848x848px. Graded on the modified Davis scale:
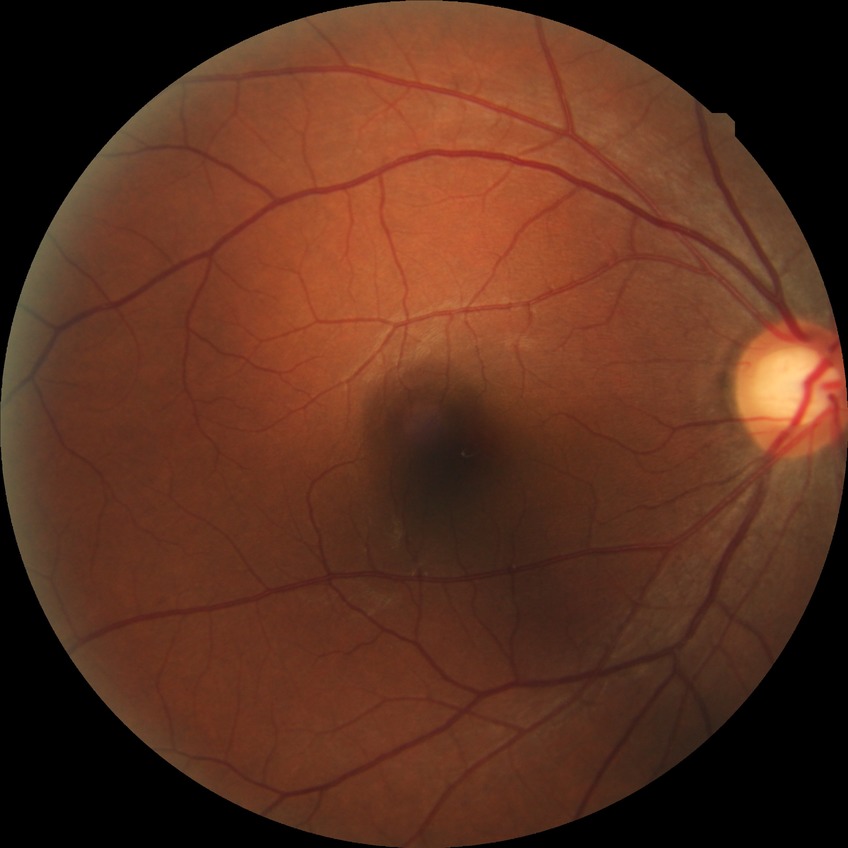 Diabetic retinopathy (DR): no diabetic retinopathy (NDR).